Pediatric wide-field fundus photograph — 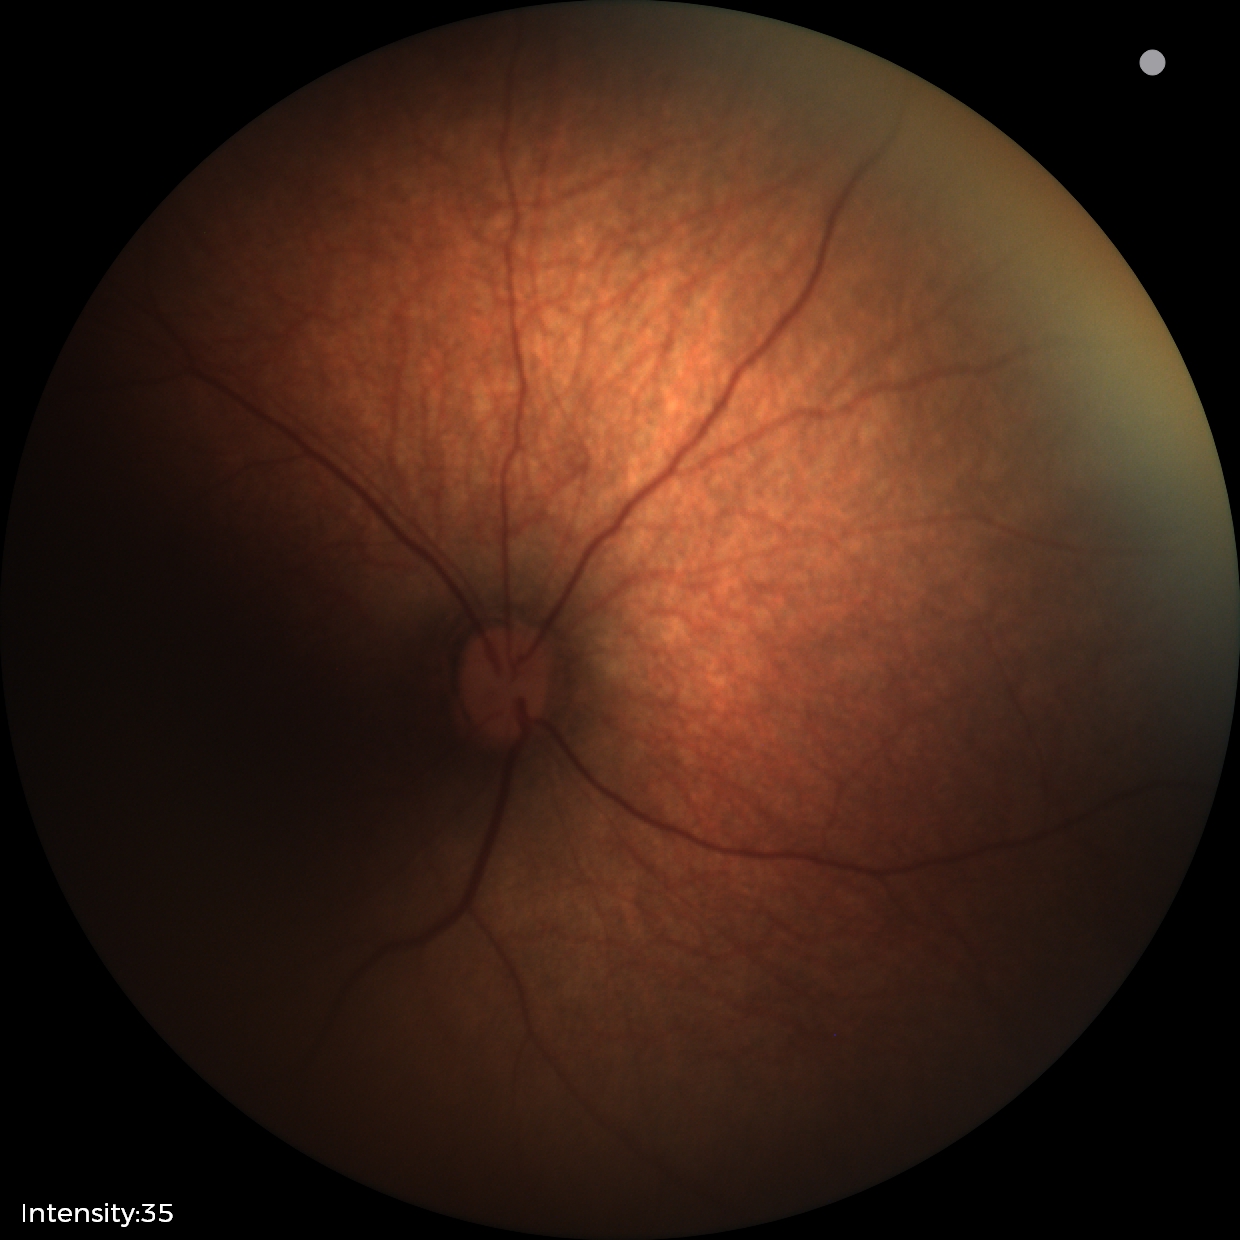

Assessment: no pathology identified